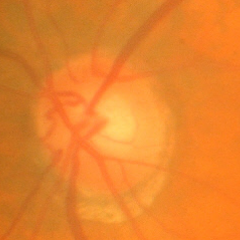 Glaucoma status = no signs of glaucoma.